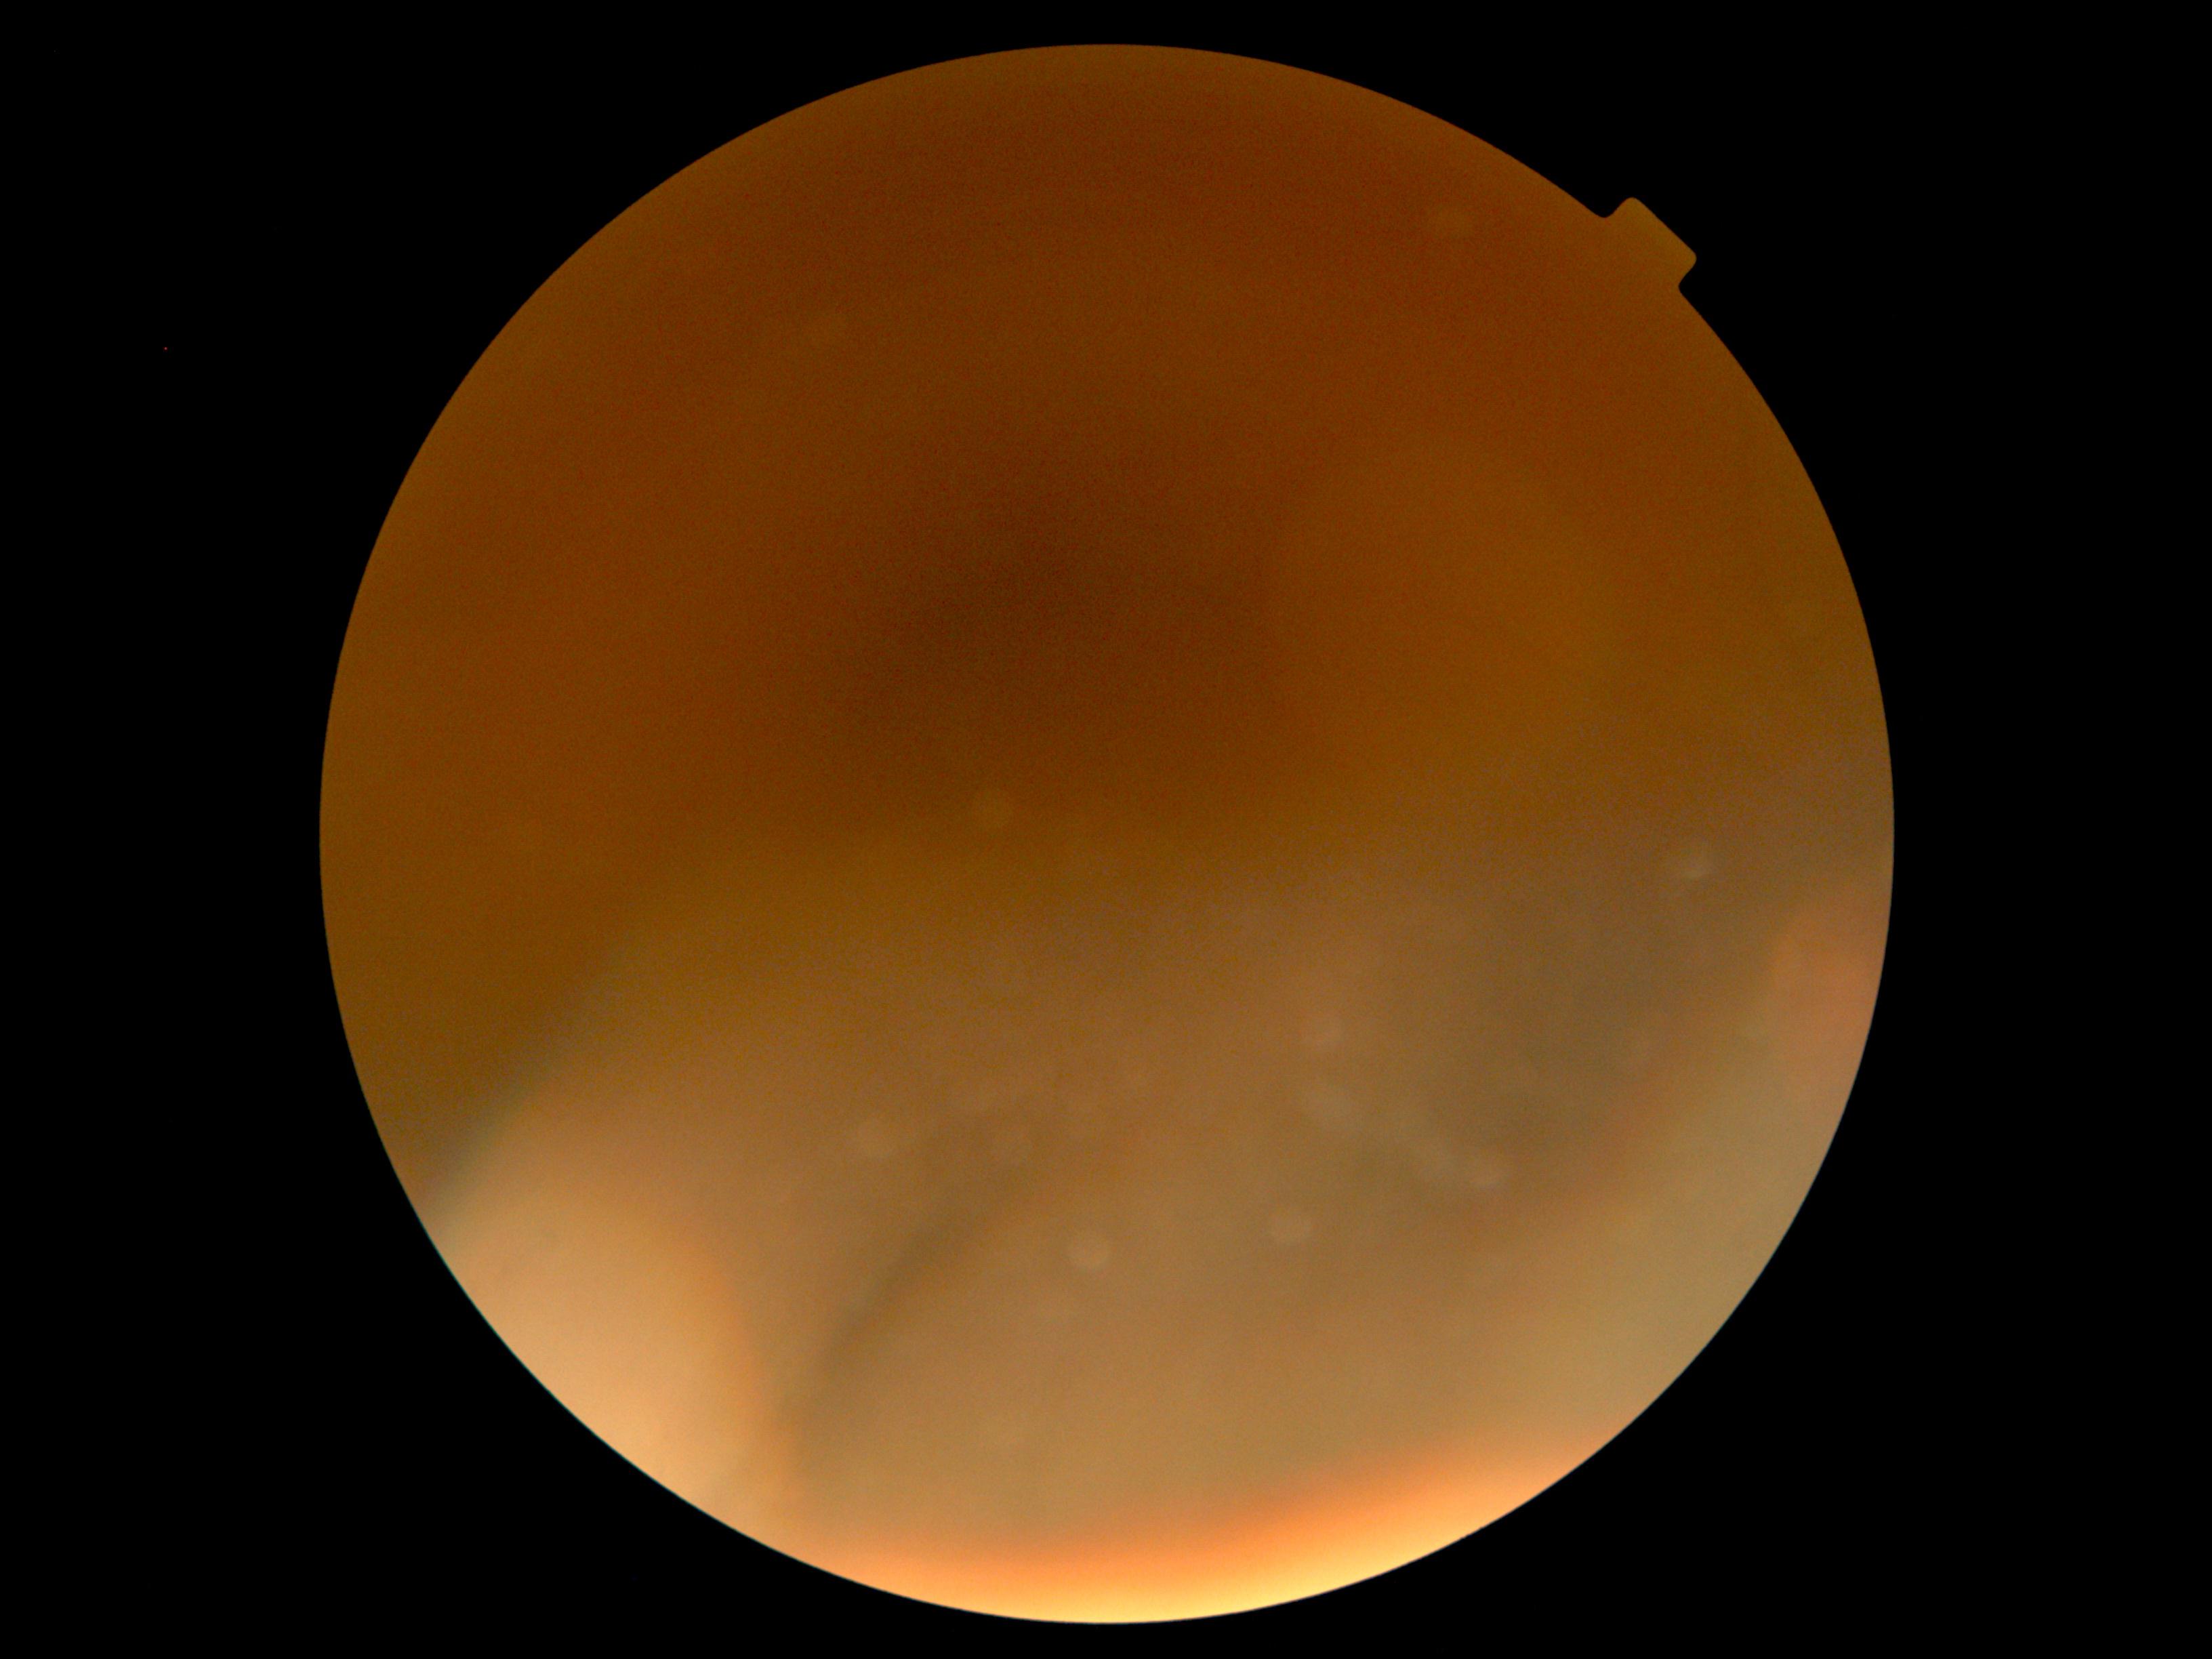
{"dr_grade": "ungradable due to poor image quality", "quality": "too poor for DR grading"}